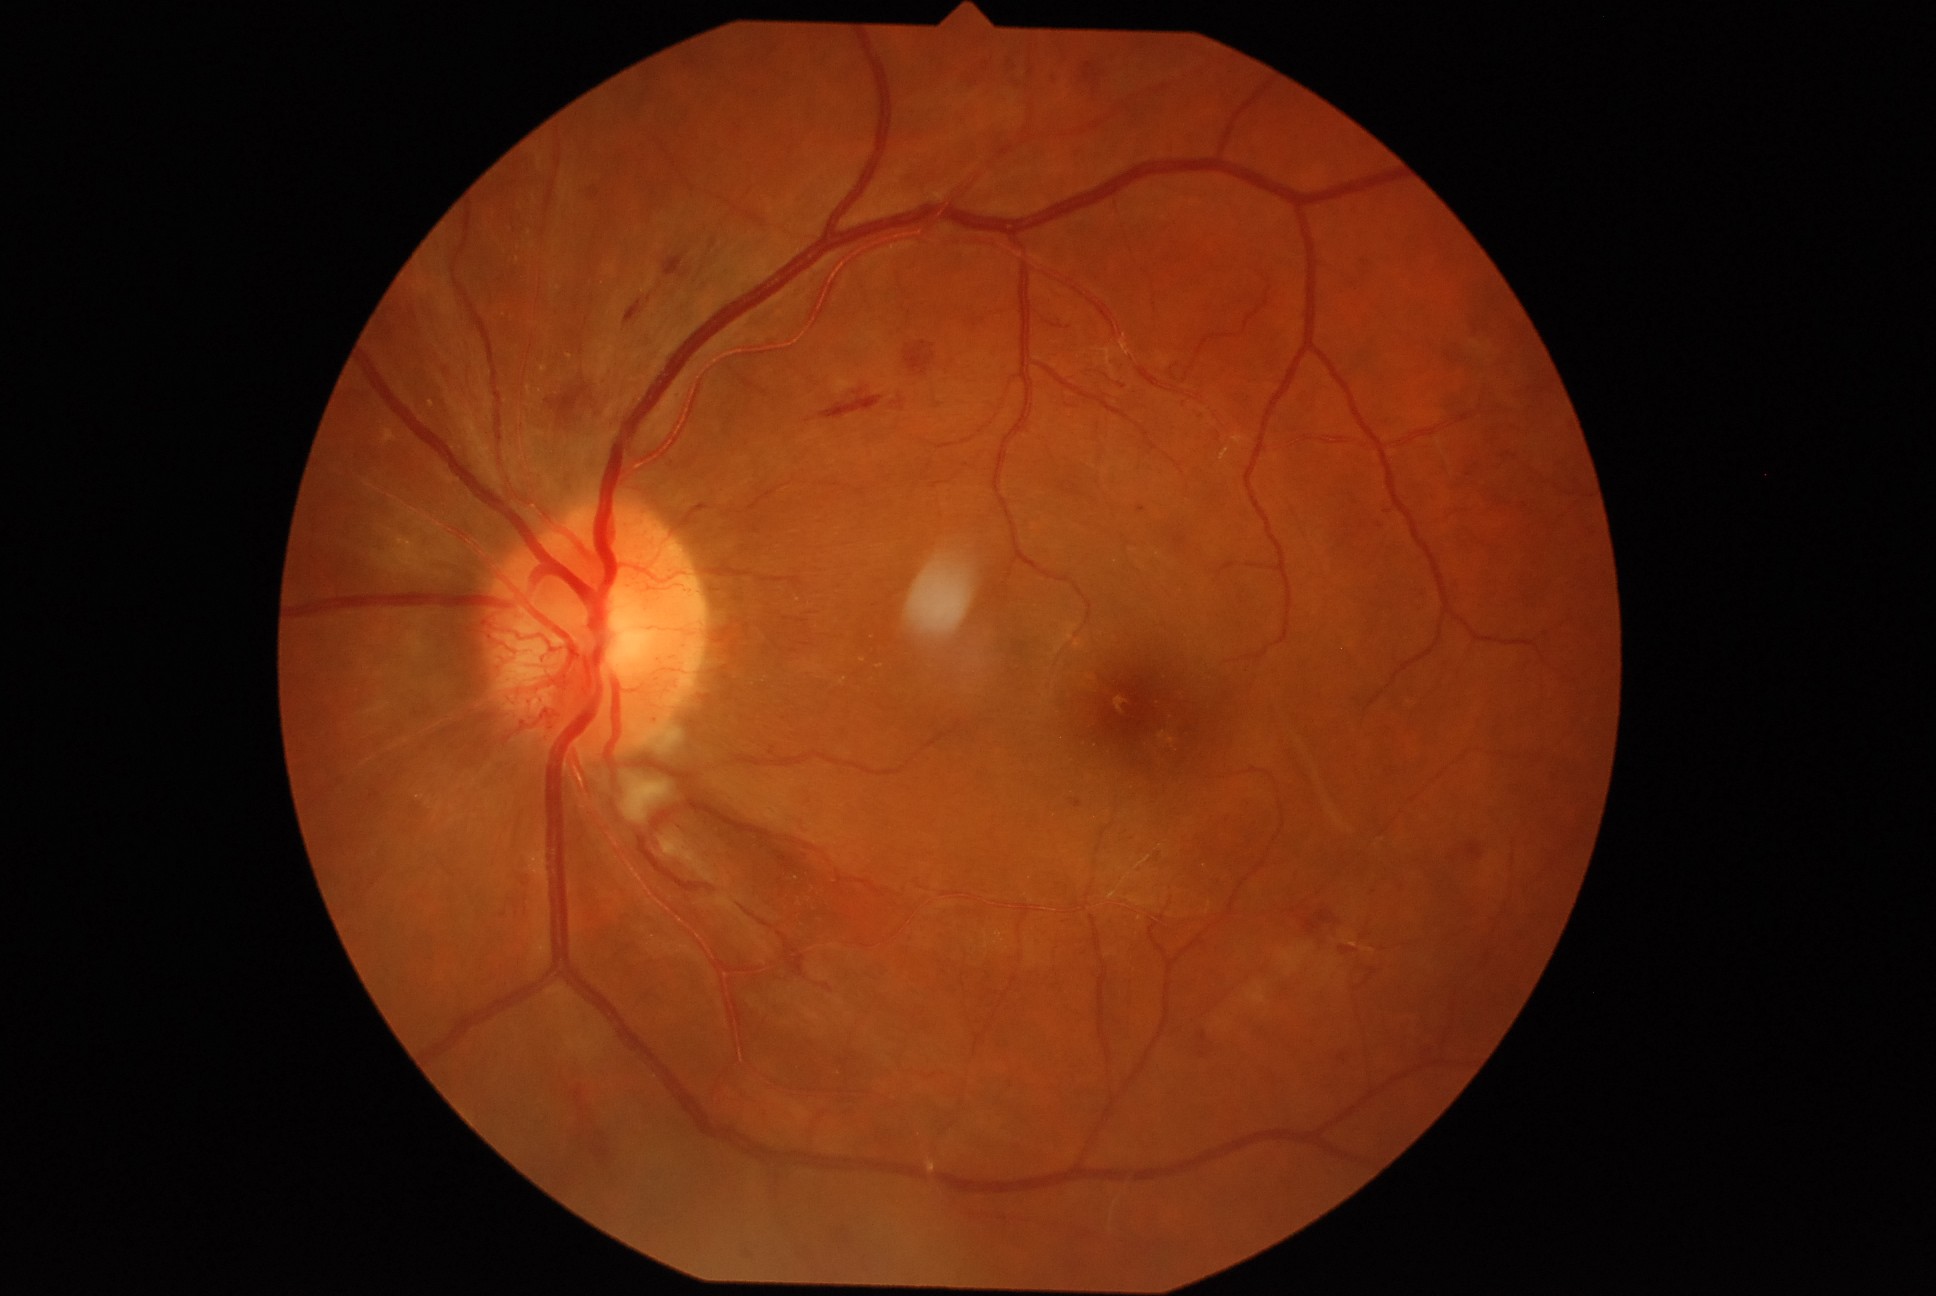 Retinopathy grade: PDR (4)
A subset of detected lesions:
hemorrhages (more not shown) = rect(1302, 919, 1320, 936), rect(1052, 71, 1057, 88), rect(624, 299, 645, 326), rect(820, 389, 883, 420), rect(1315, 911, 1333, 924), rect(1335, 1054, 1349, 1066), rect(1340, 946, 1361, 957), rect(892, 397, 906, 412), rect(904, 343, 935, 376), rect(797, 620, 808, 624)
Additional small hemorrhages near x=649 y=300